Color fundus photograph, image size 240x240 — 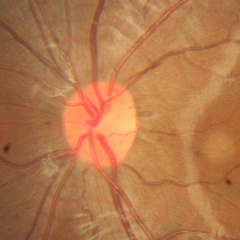

Impression = no glaucomatous findings.